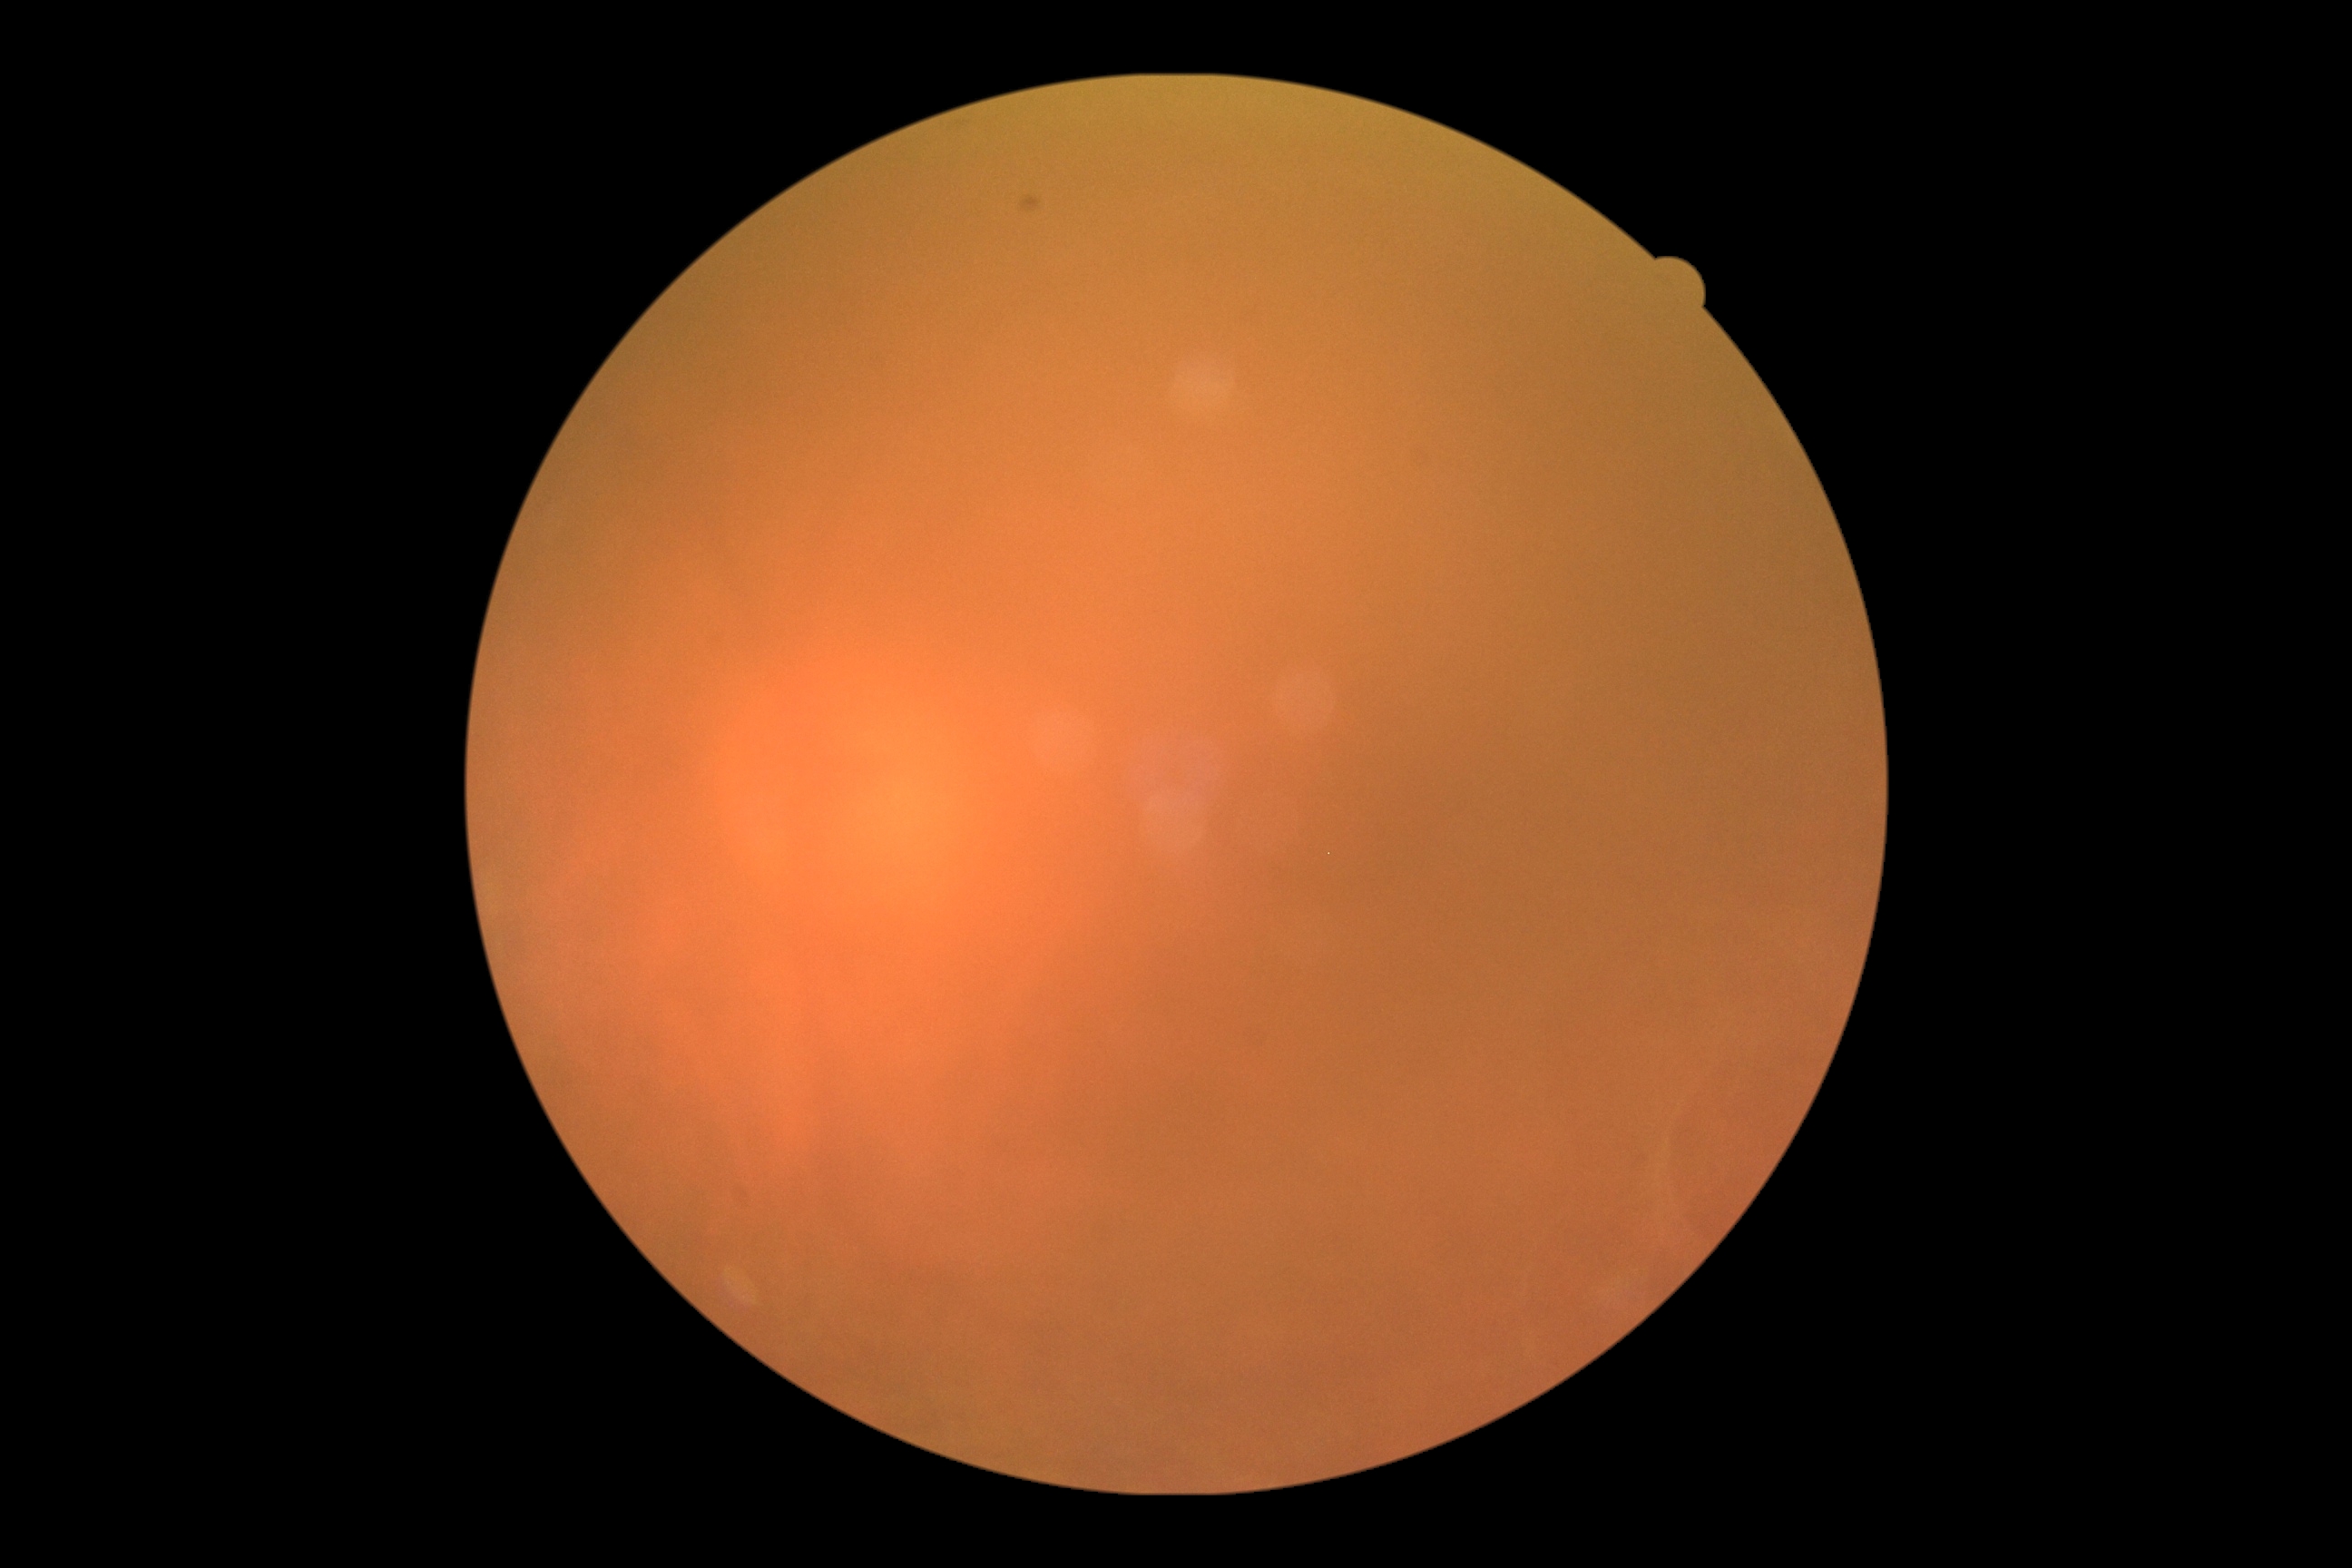 Diabetic retinopathy (DR): ungradable due to poor image quality. Quality too poor to assess for DR.